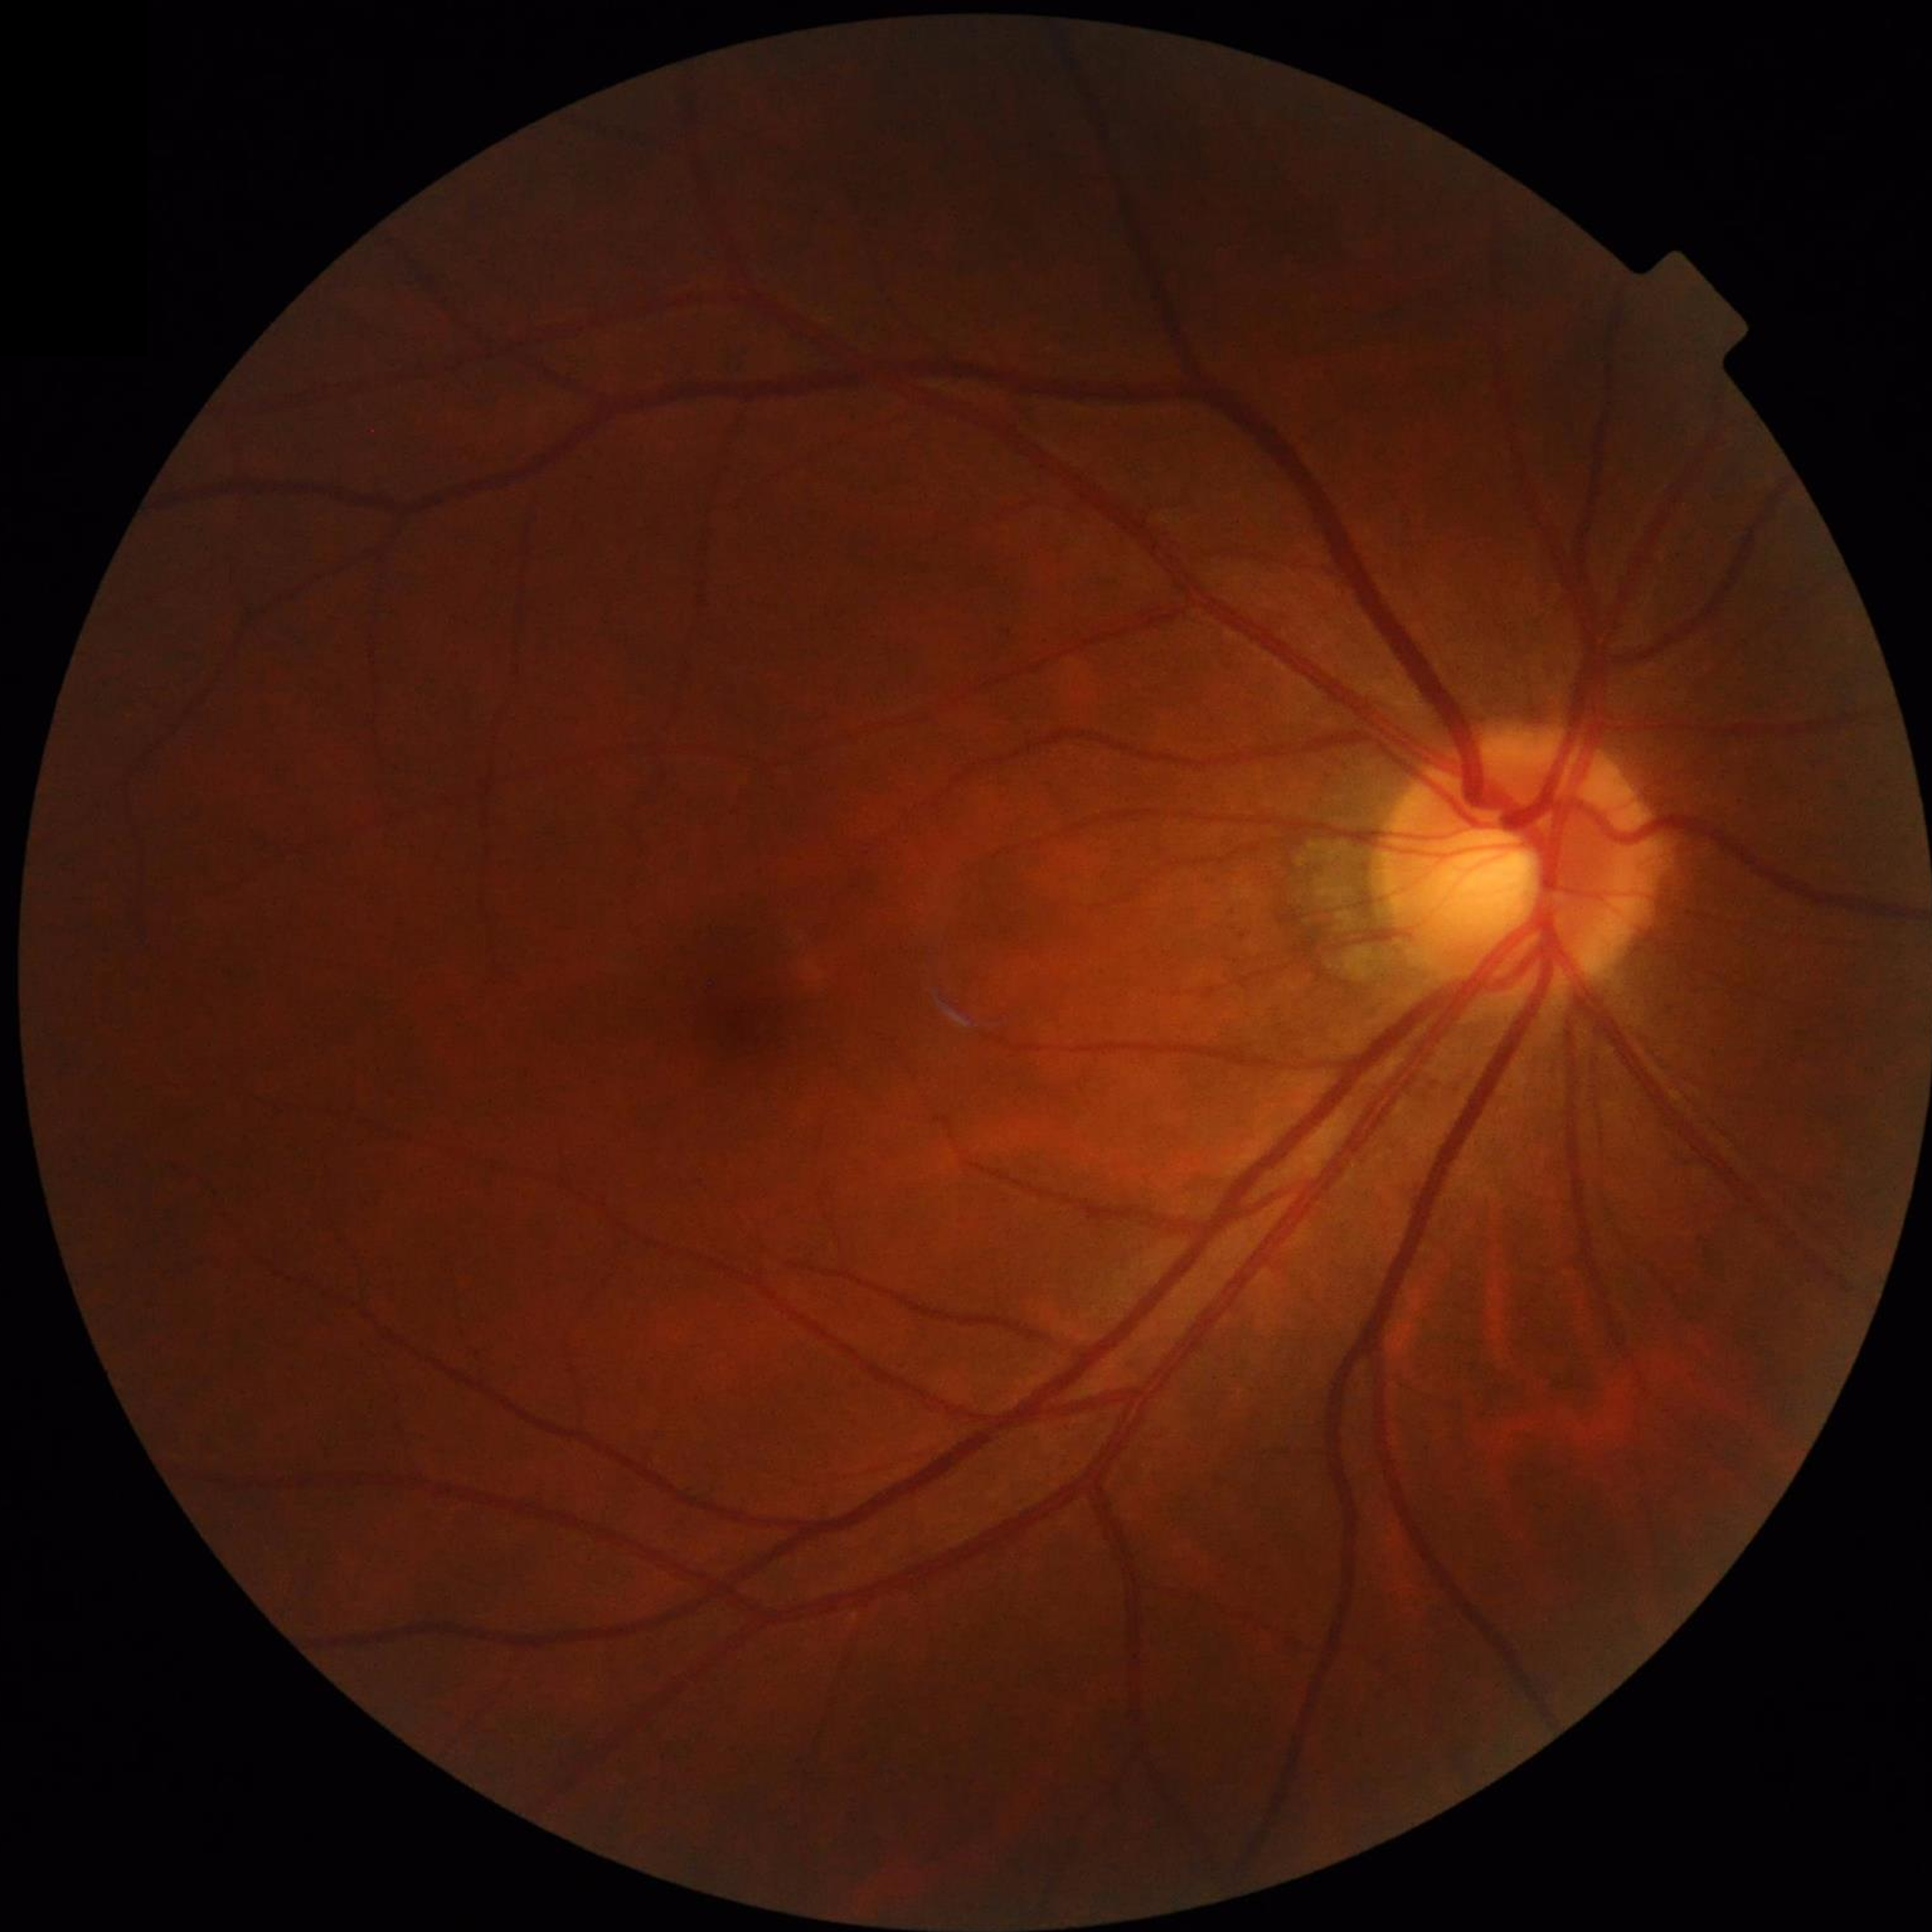
Disease class: control (no AMD/DR/glaucoma).